DR severity per modified Davis staging; fundus photo; image size 848x848: 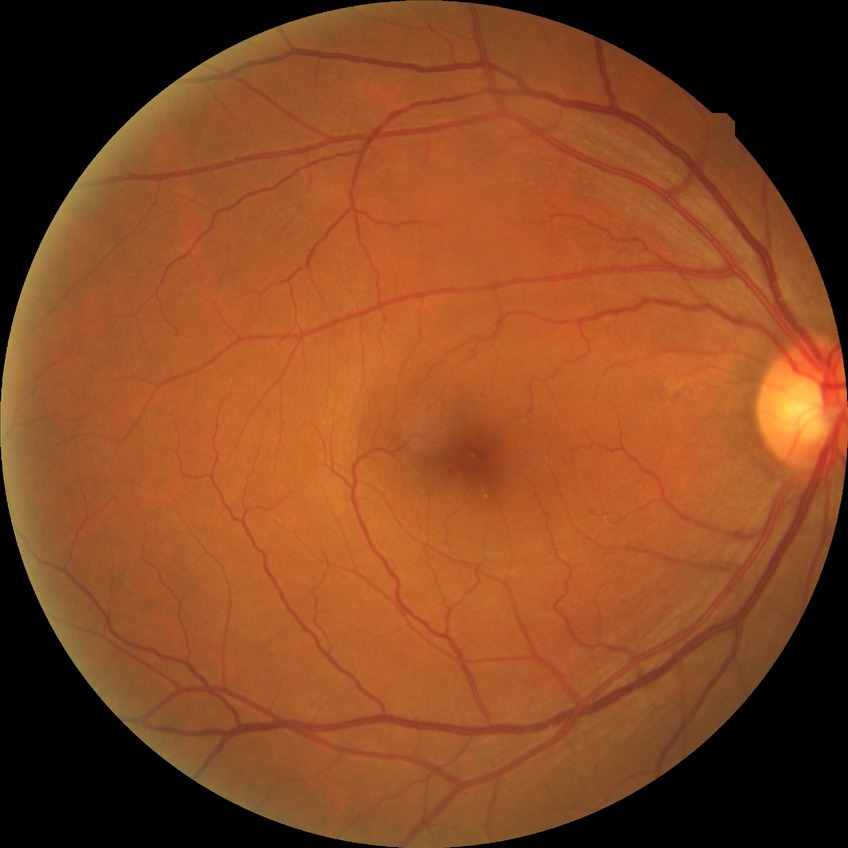
Modified Davis grade is SDR.